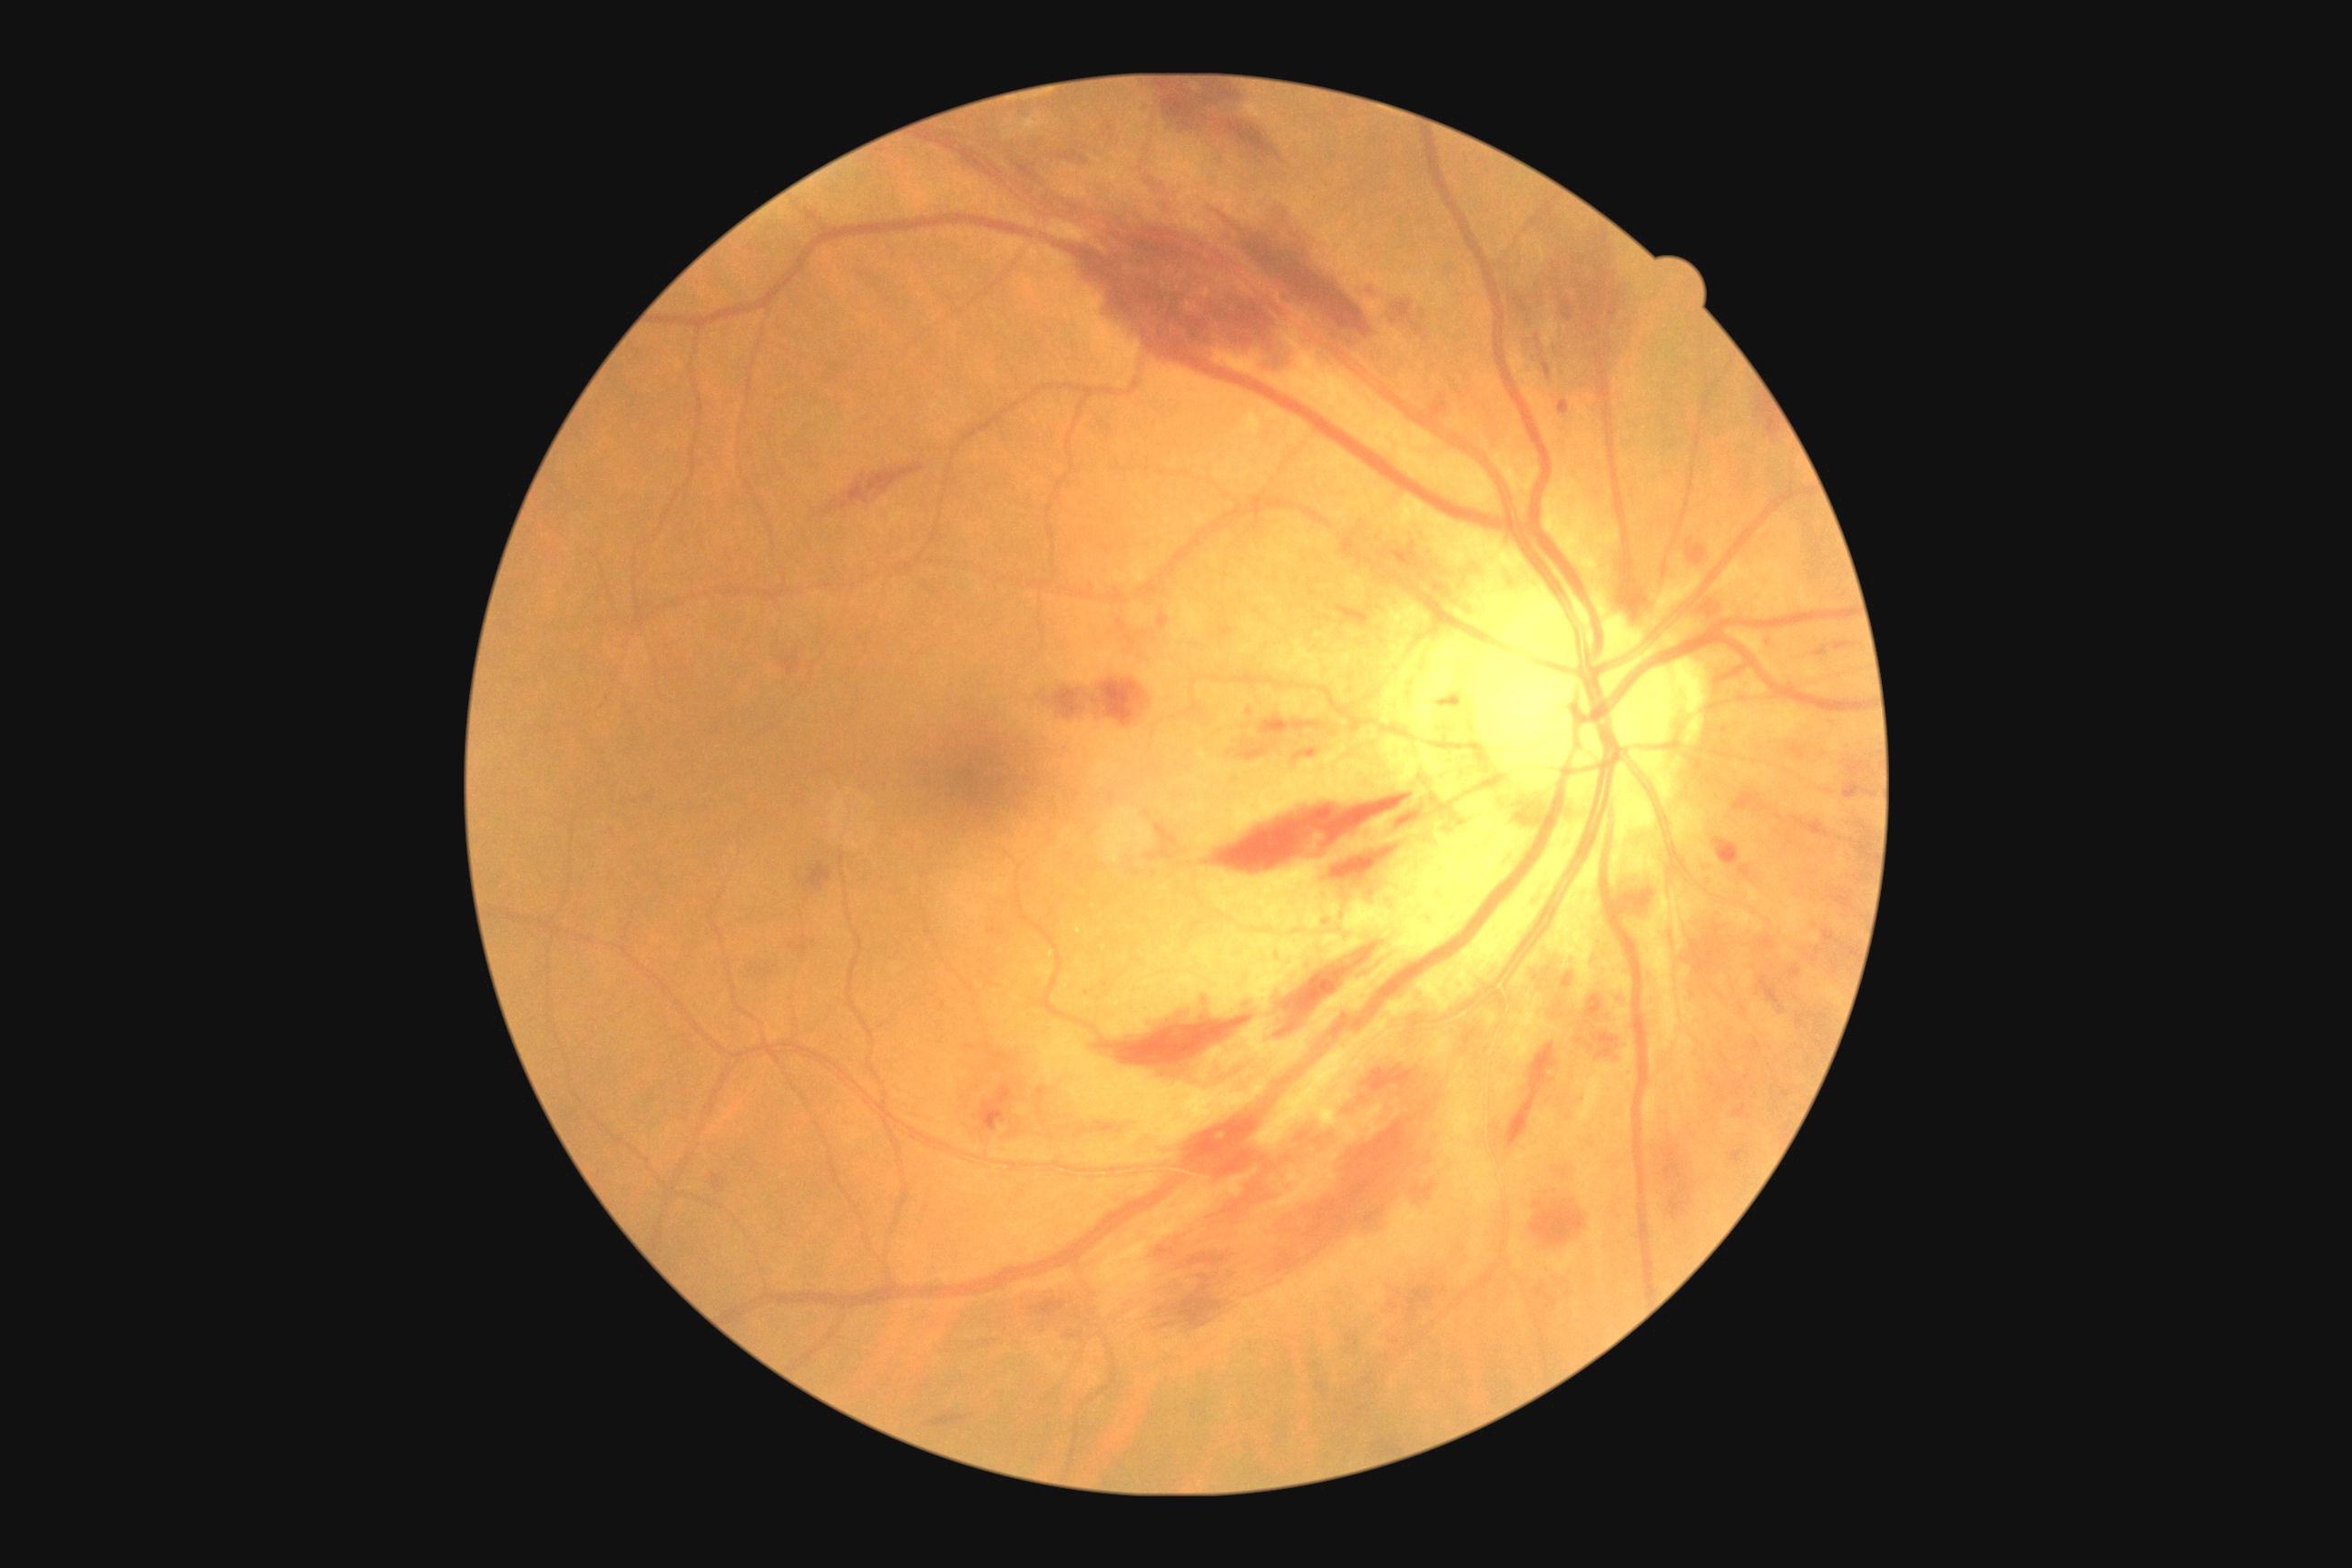 Diabetic retinopathy (DR) is moderate NPDR (grade 2)
Representative lesions:
hard exudates (EXs): <region>1075, 925, 1081, 936</region>
Small EXs near 1052, 954; 1095, 907; 1566, 1058
soft exudates (SEs): none identified
hemorrhages (HEs) (partial): <region>1039, 1088, 1048, 1095</region>; <region>1057, 148, 1088, 164</region>; <region>1010, 157, 1039, 184</region>; <region>1335, 602, 1369, 622</region>; <region>710, 1173, 725, 1193</region>; <region>1431, 698, 1456, 707</region>; <region>1587, 995, 1603, 1021</region>; <region>1507, 1044, 1558, 1148</region>; <region>1536, 1286, 1558, 1309</region>; <region>1153, 1075, 1456, 1328</region>; <region>1618, 874, 1660, 925</region>; <region>1360, 286, 1380, 299</region>; <region>1683, 914, 1814, 1015</region>; <region>1220, 625, 1233, 636</region>; <region>1407, 1286, 1440, 1315</region>; <region>1257, 714, 1331, 732</region>; <region>1063, 1328, 1084, 1335</region>
microaneurysms (MAs): <region>1558, 402, 1569, 415</region>
Small MAs near 1088, 993; 1105, 985; 1629, 1073; 1582, 1099; 1249, 712